Color fundus photograph; FOV: 45 degrees; 2184 by 1682 pixels:
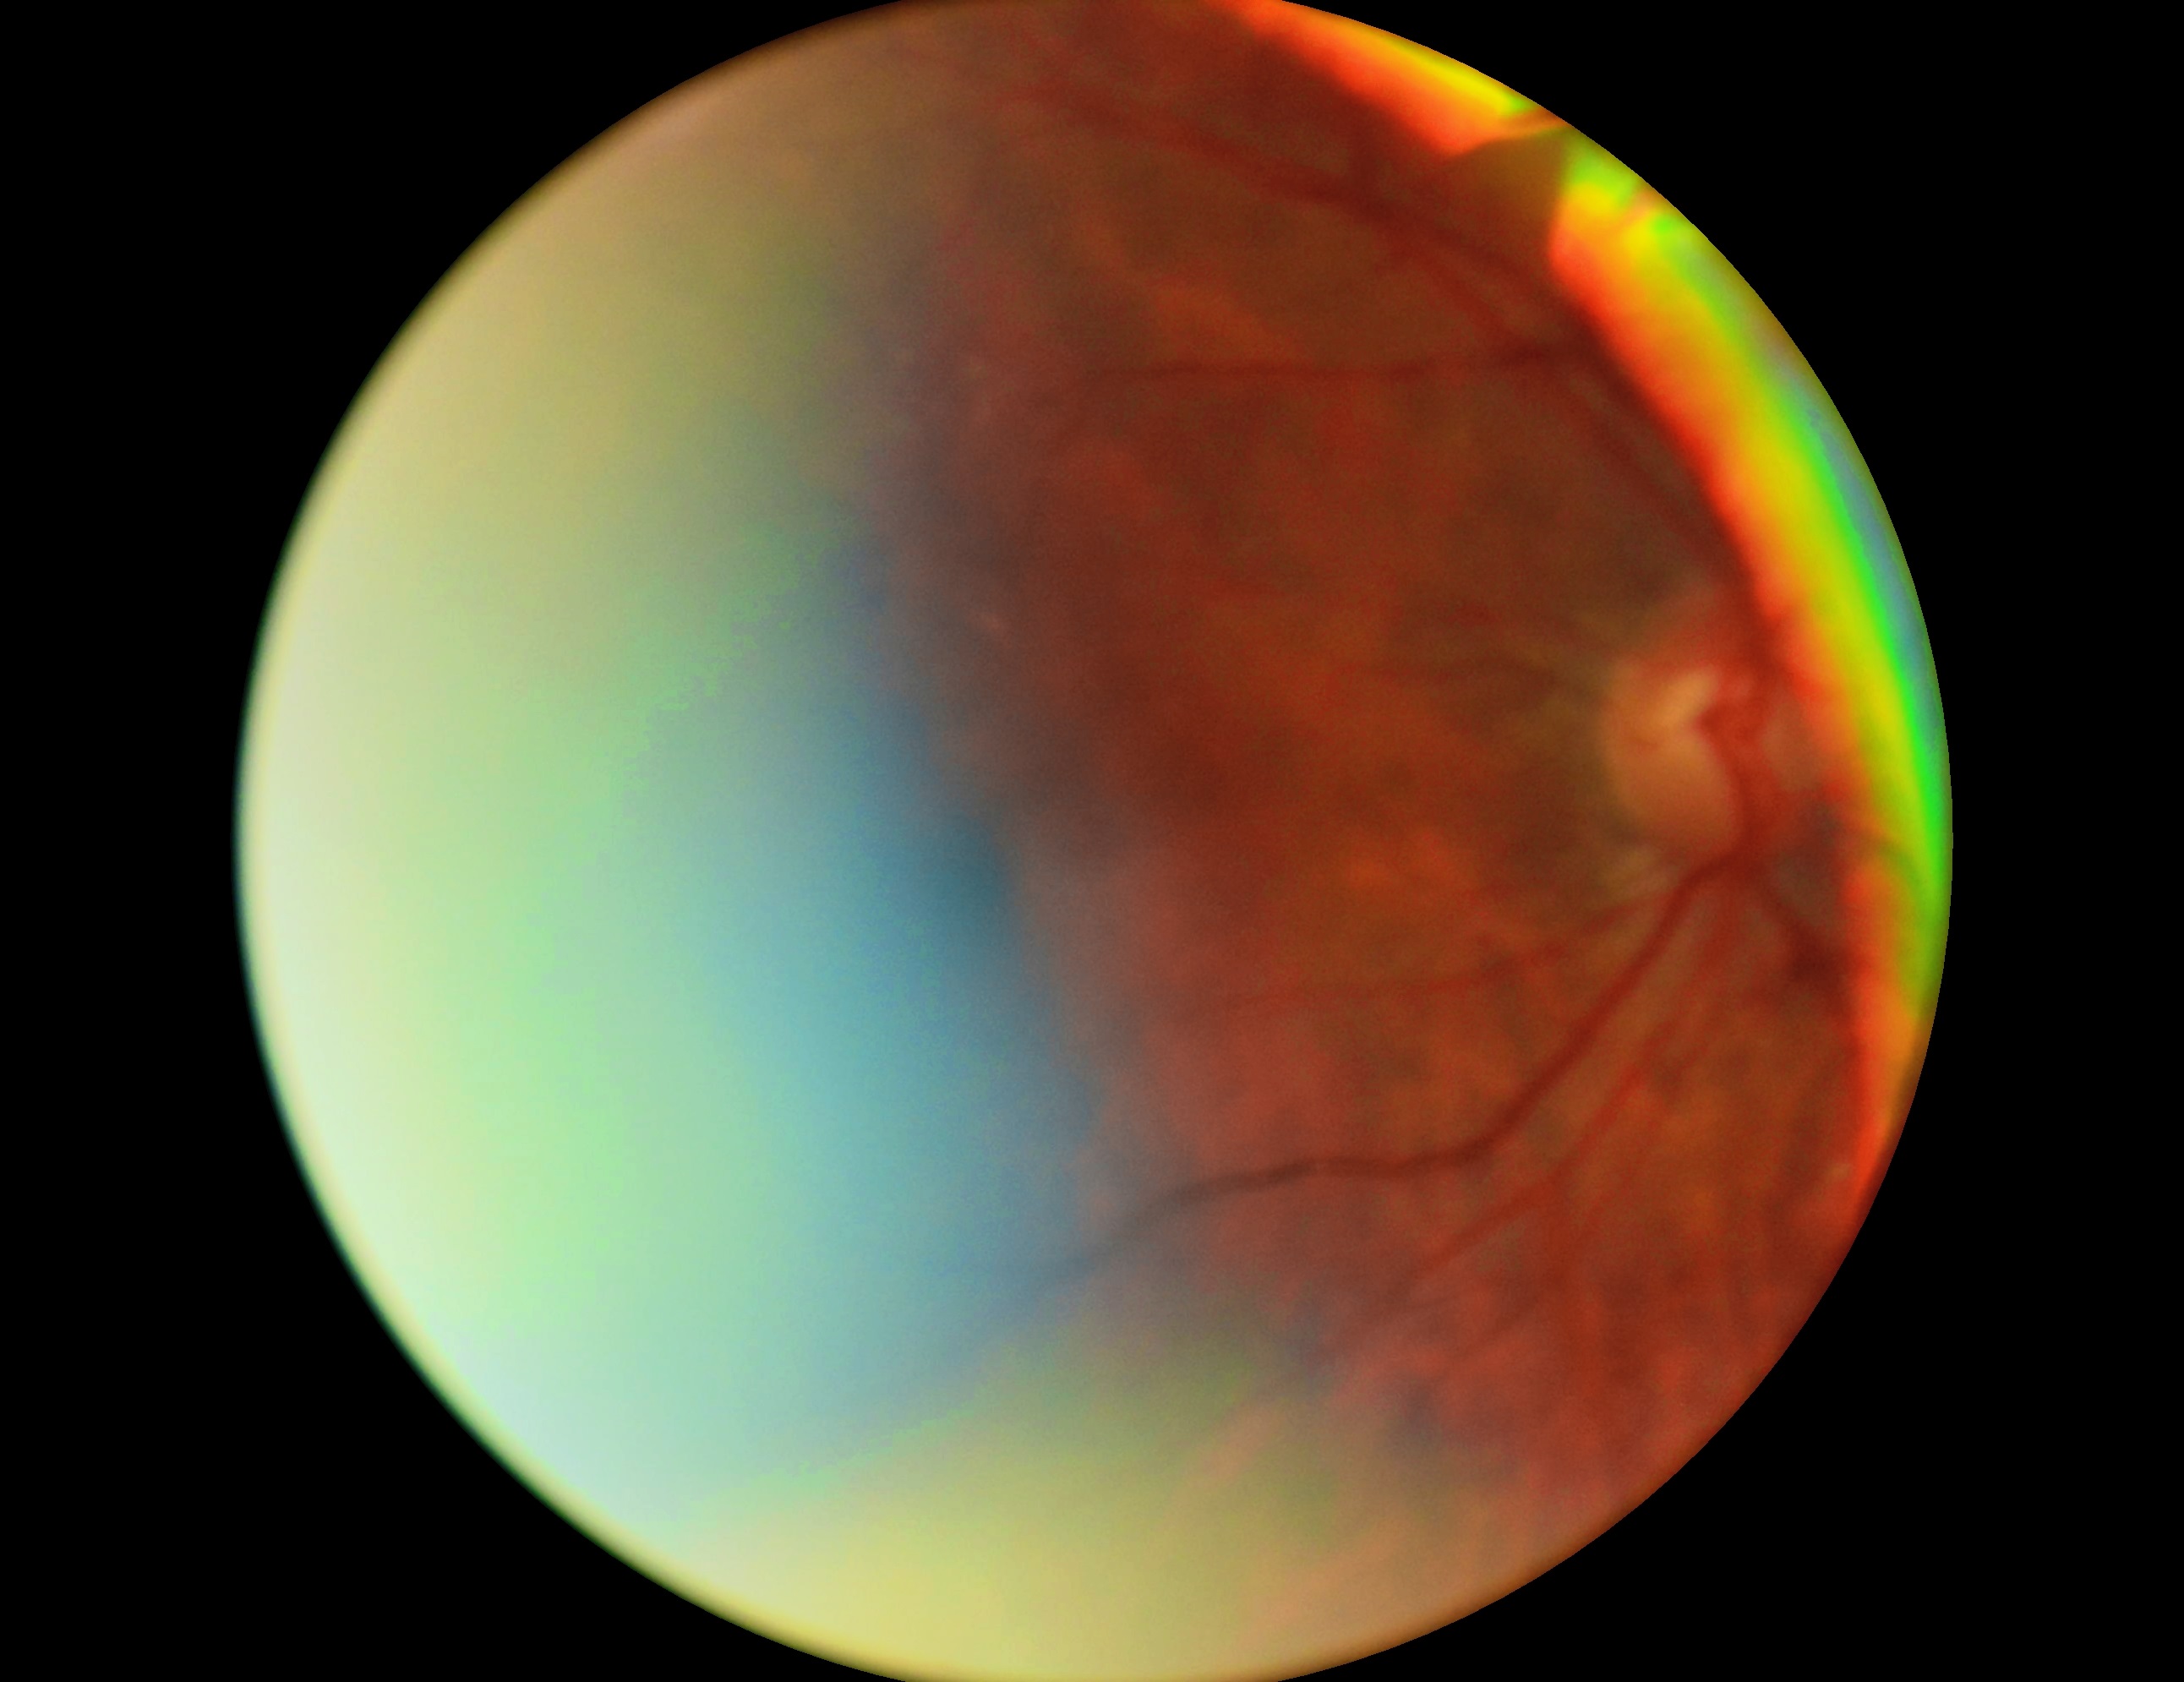 Retinopathy grade: ungradable due to poor image quality.